Color fundus image
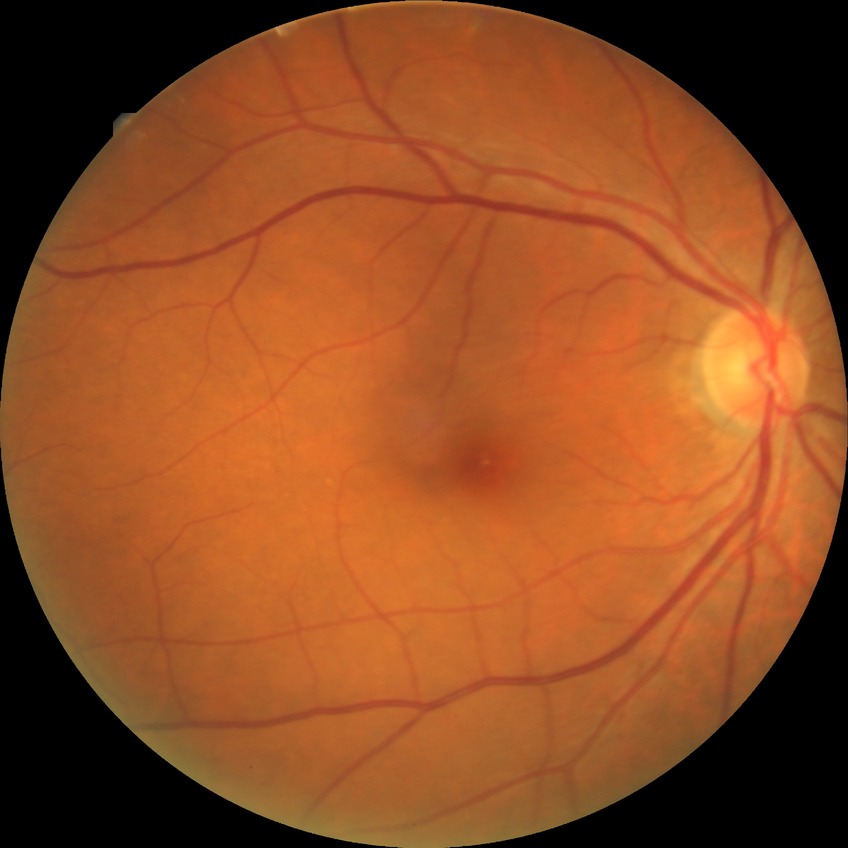
Davis grading is no diabetic retinopathy.